Fundus photo — 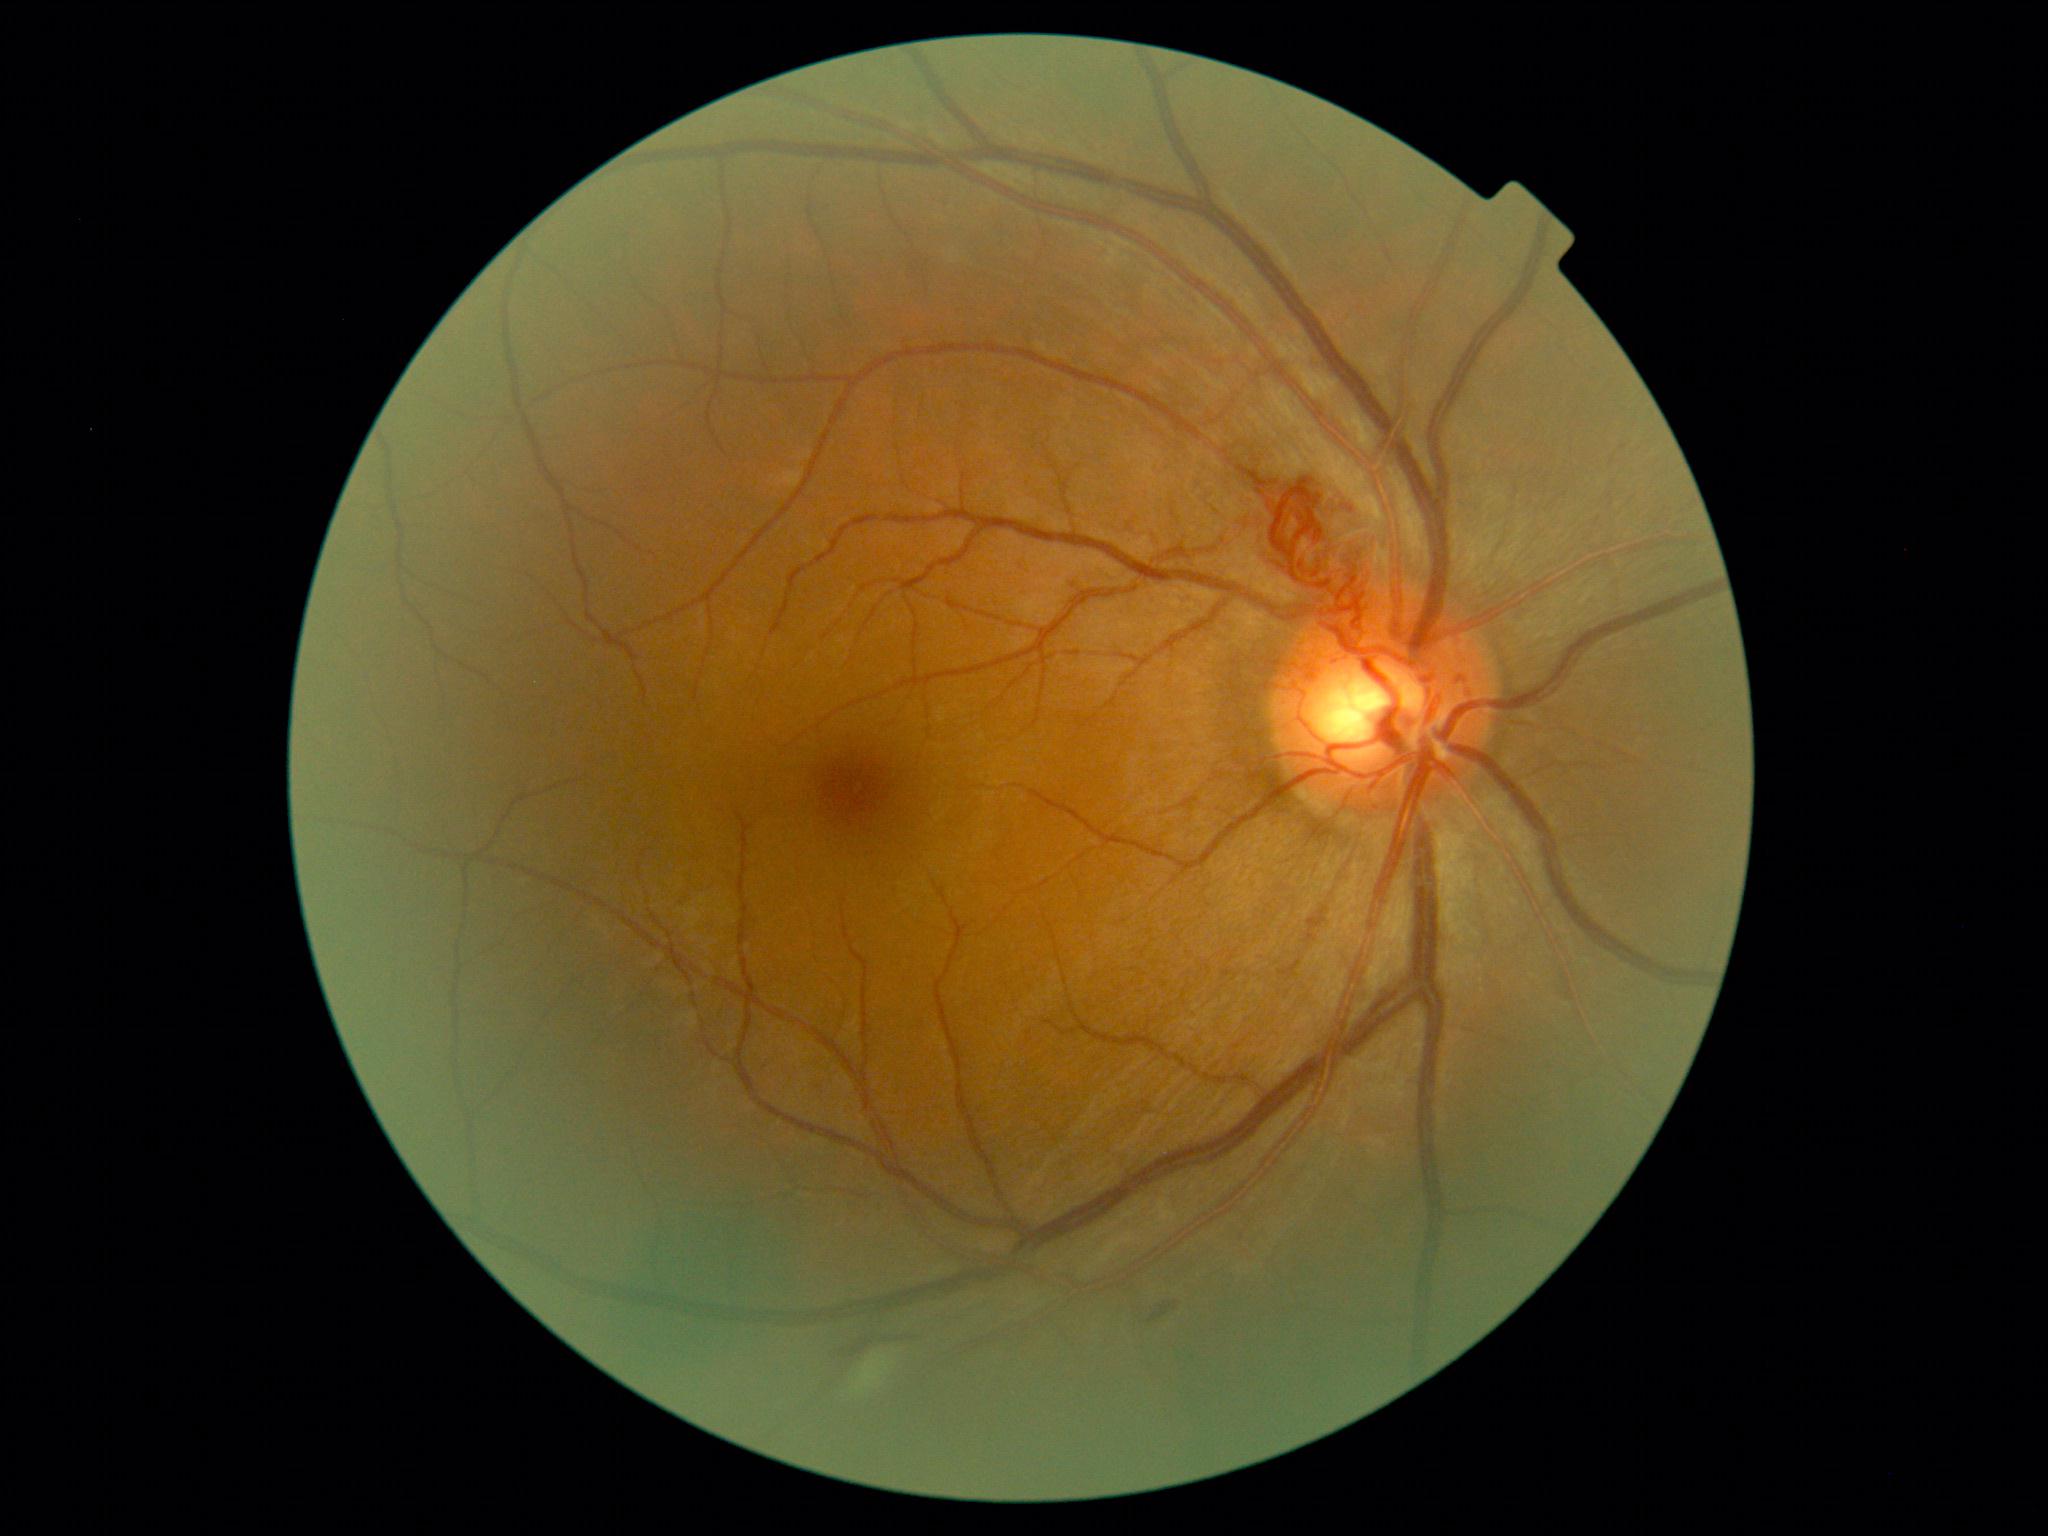
Diabetic retinopathy: 2/4.